Acquired with a NIDEK AFC-230; color fundus image; 848 x 848 pixels; 45° FOV; nonmydriatic fundus photograph:
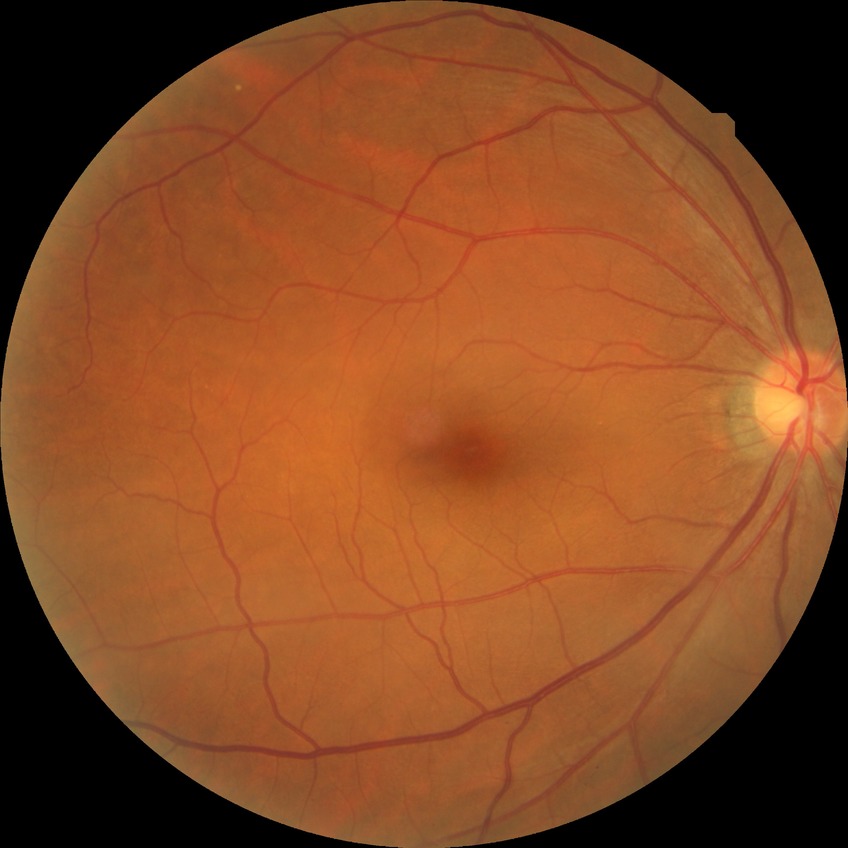 Diabetic retinopathy (DR) is NDR (no diabetic retinopathy).